45° FOV: 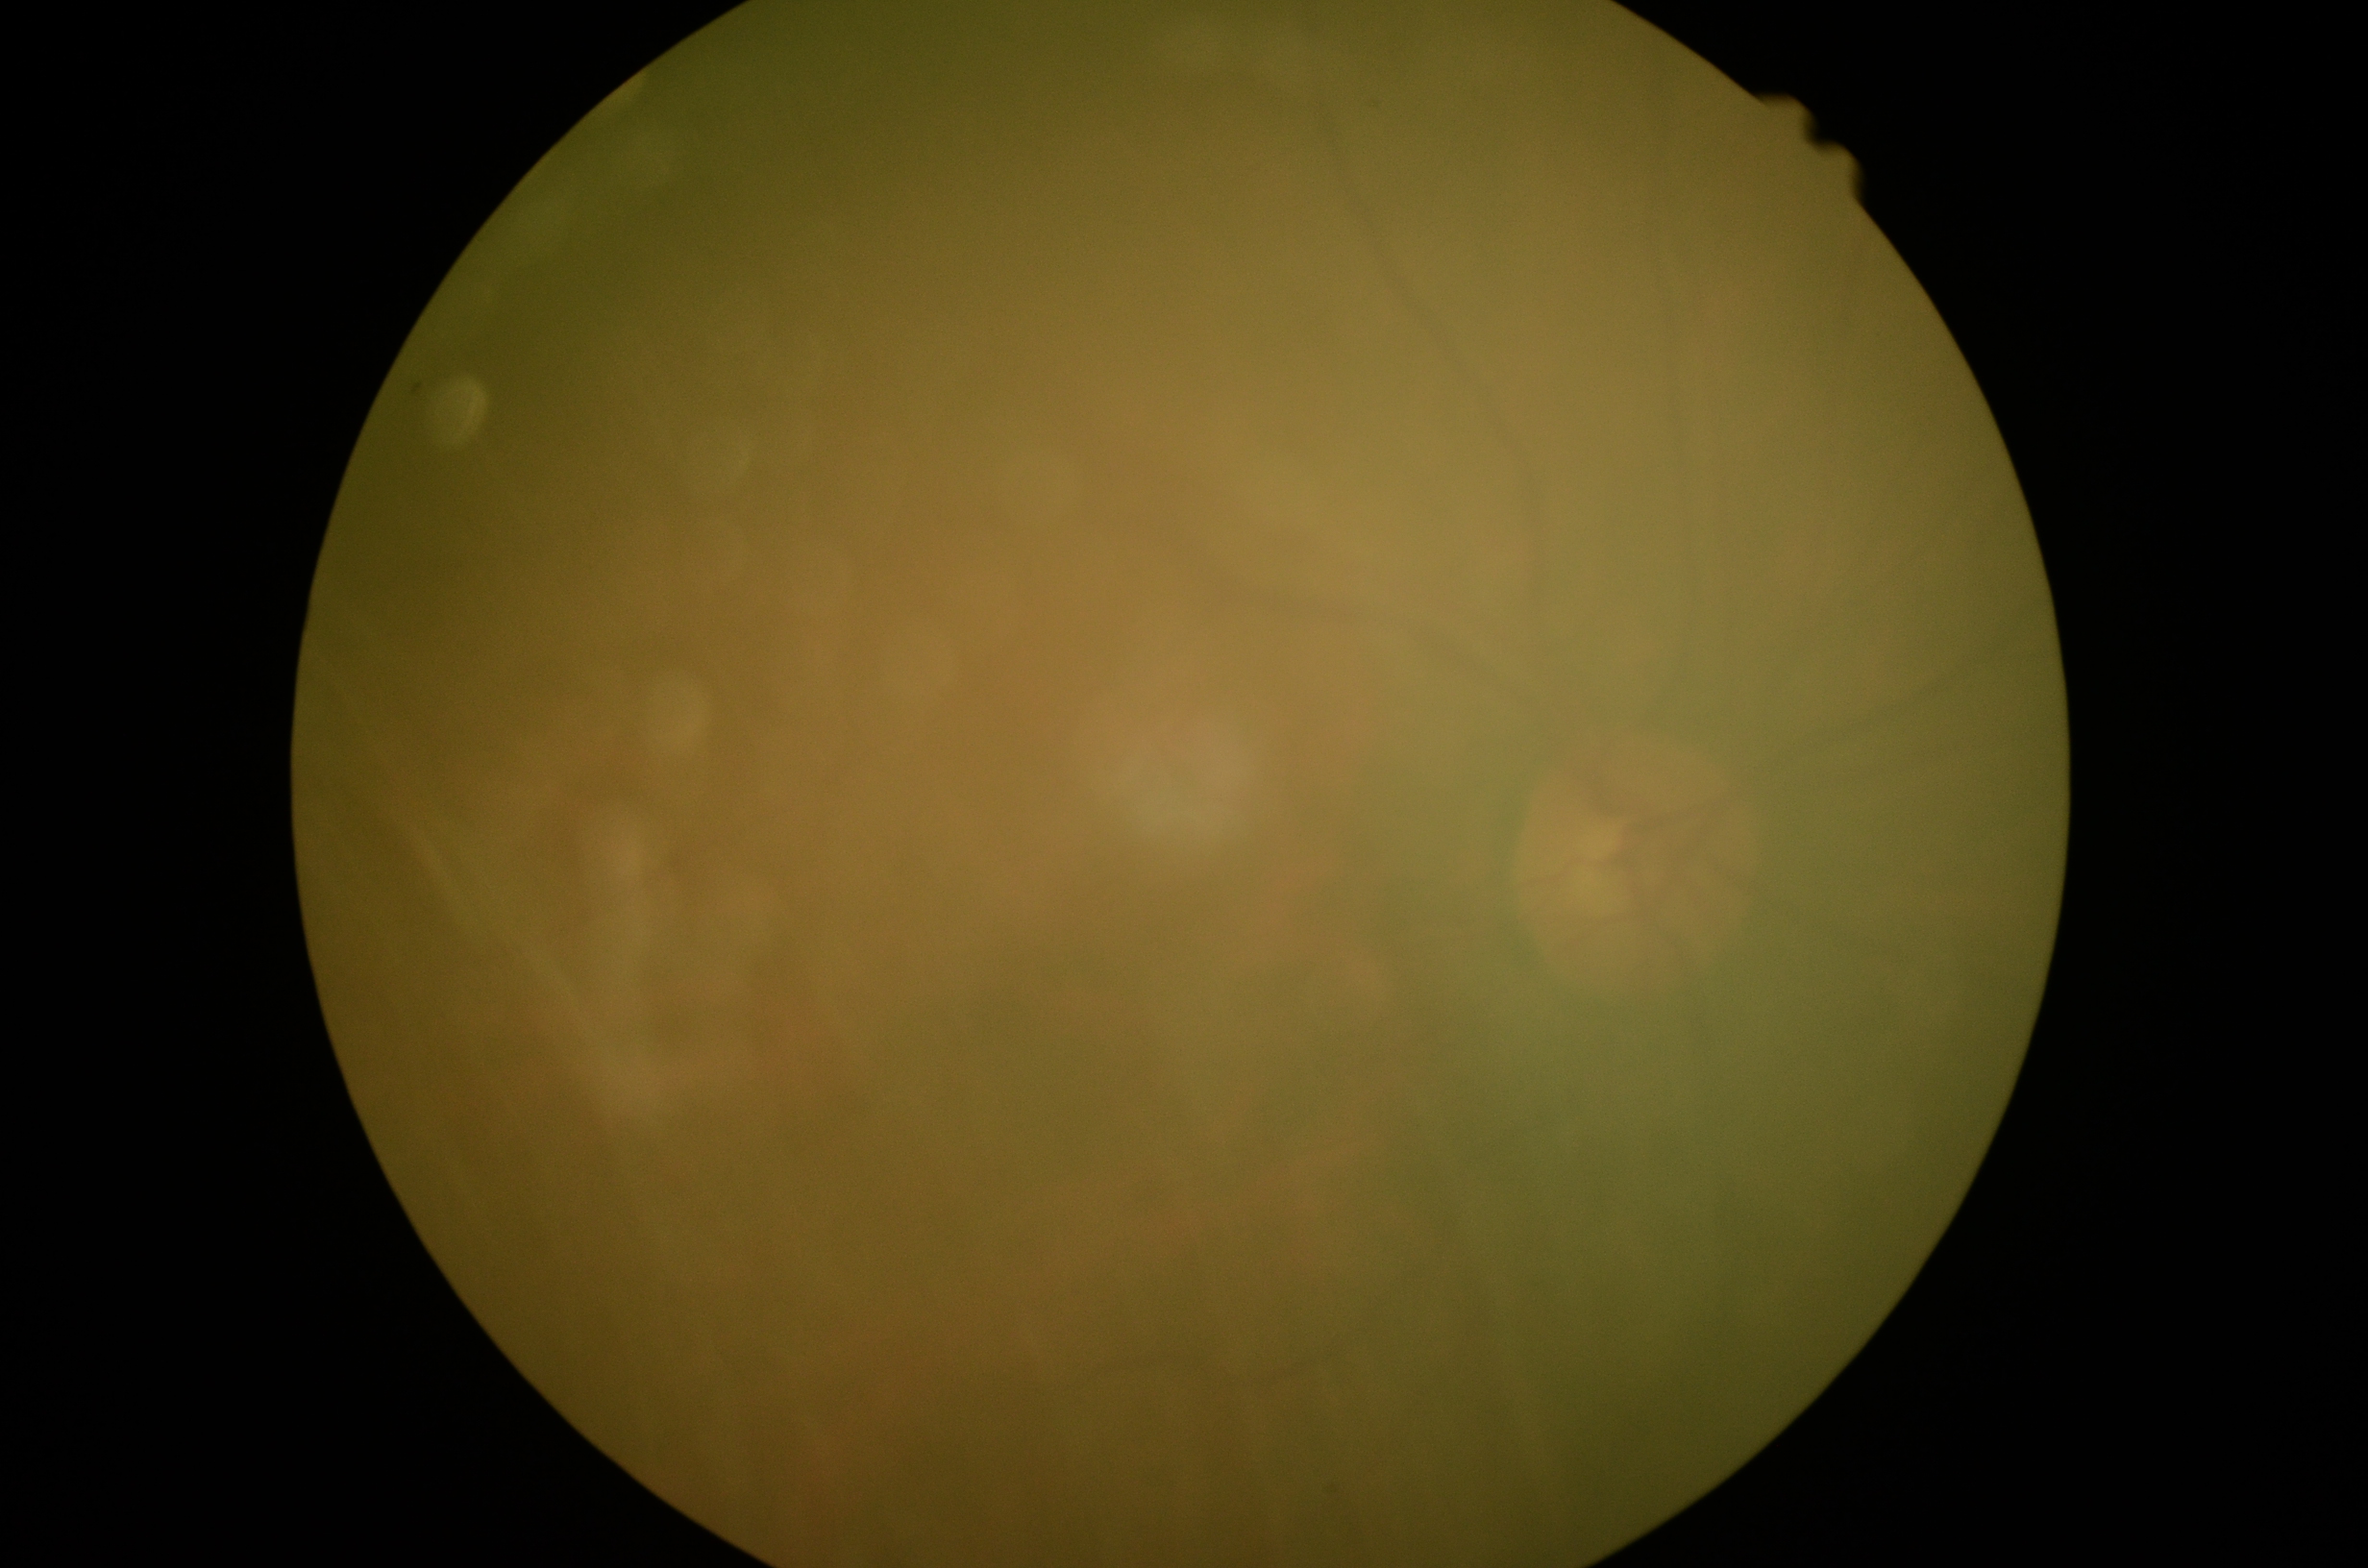

Ungradable image — DR severity cannot be determined. DR is ungradable due to poor image quality.